2352 by 1568 pixels, 45° FOV:
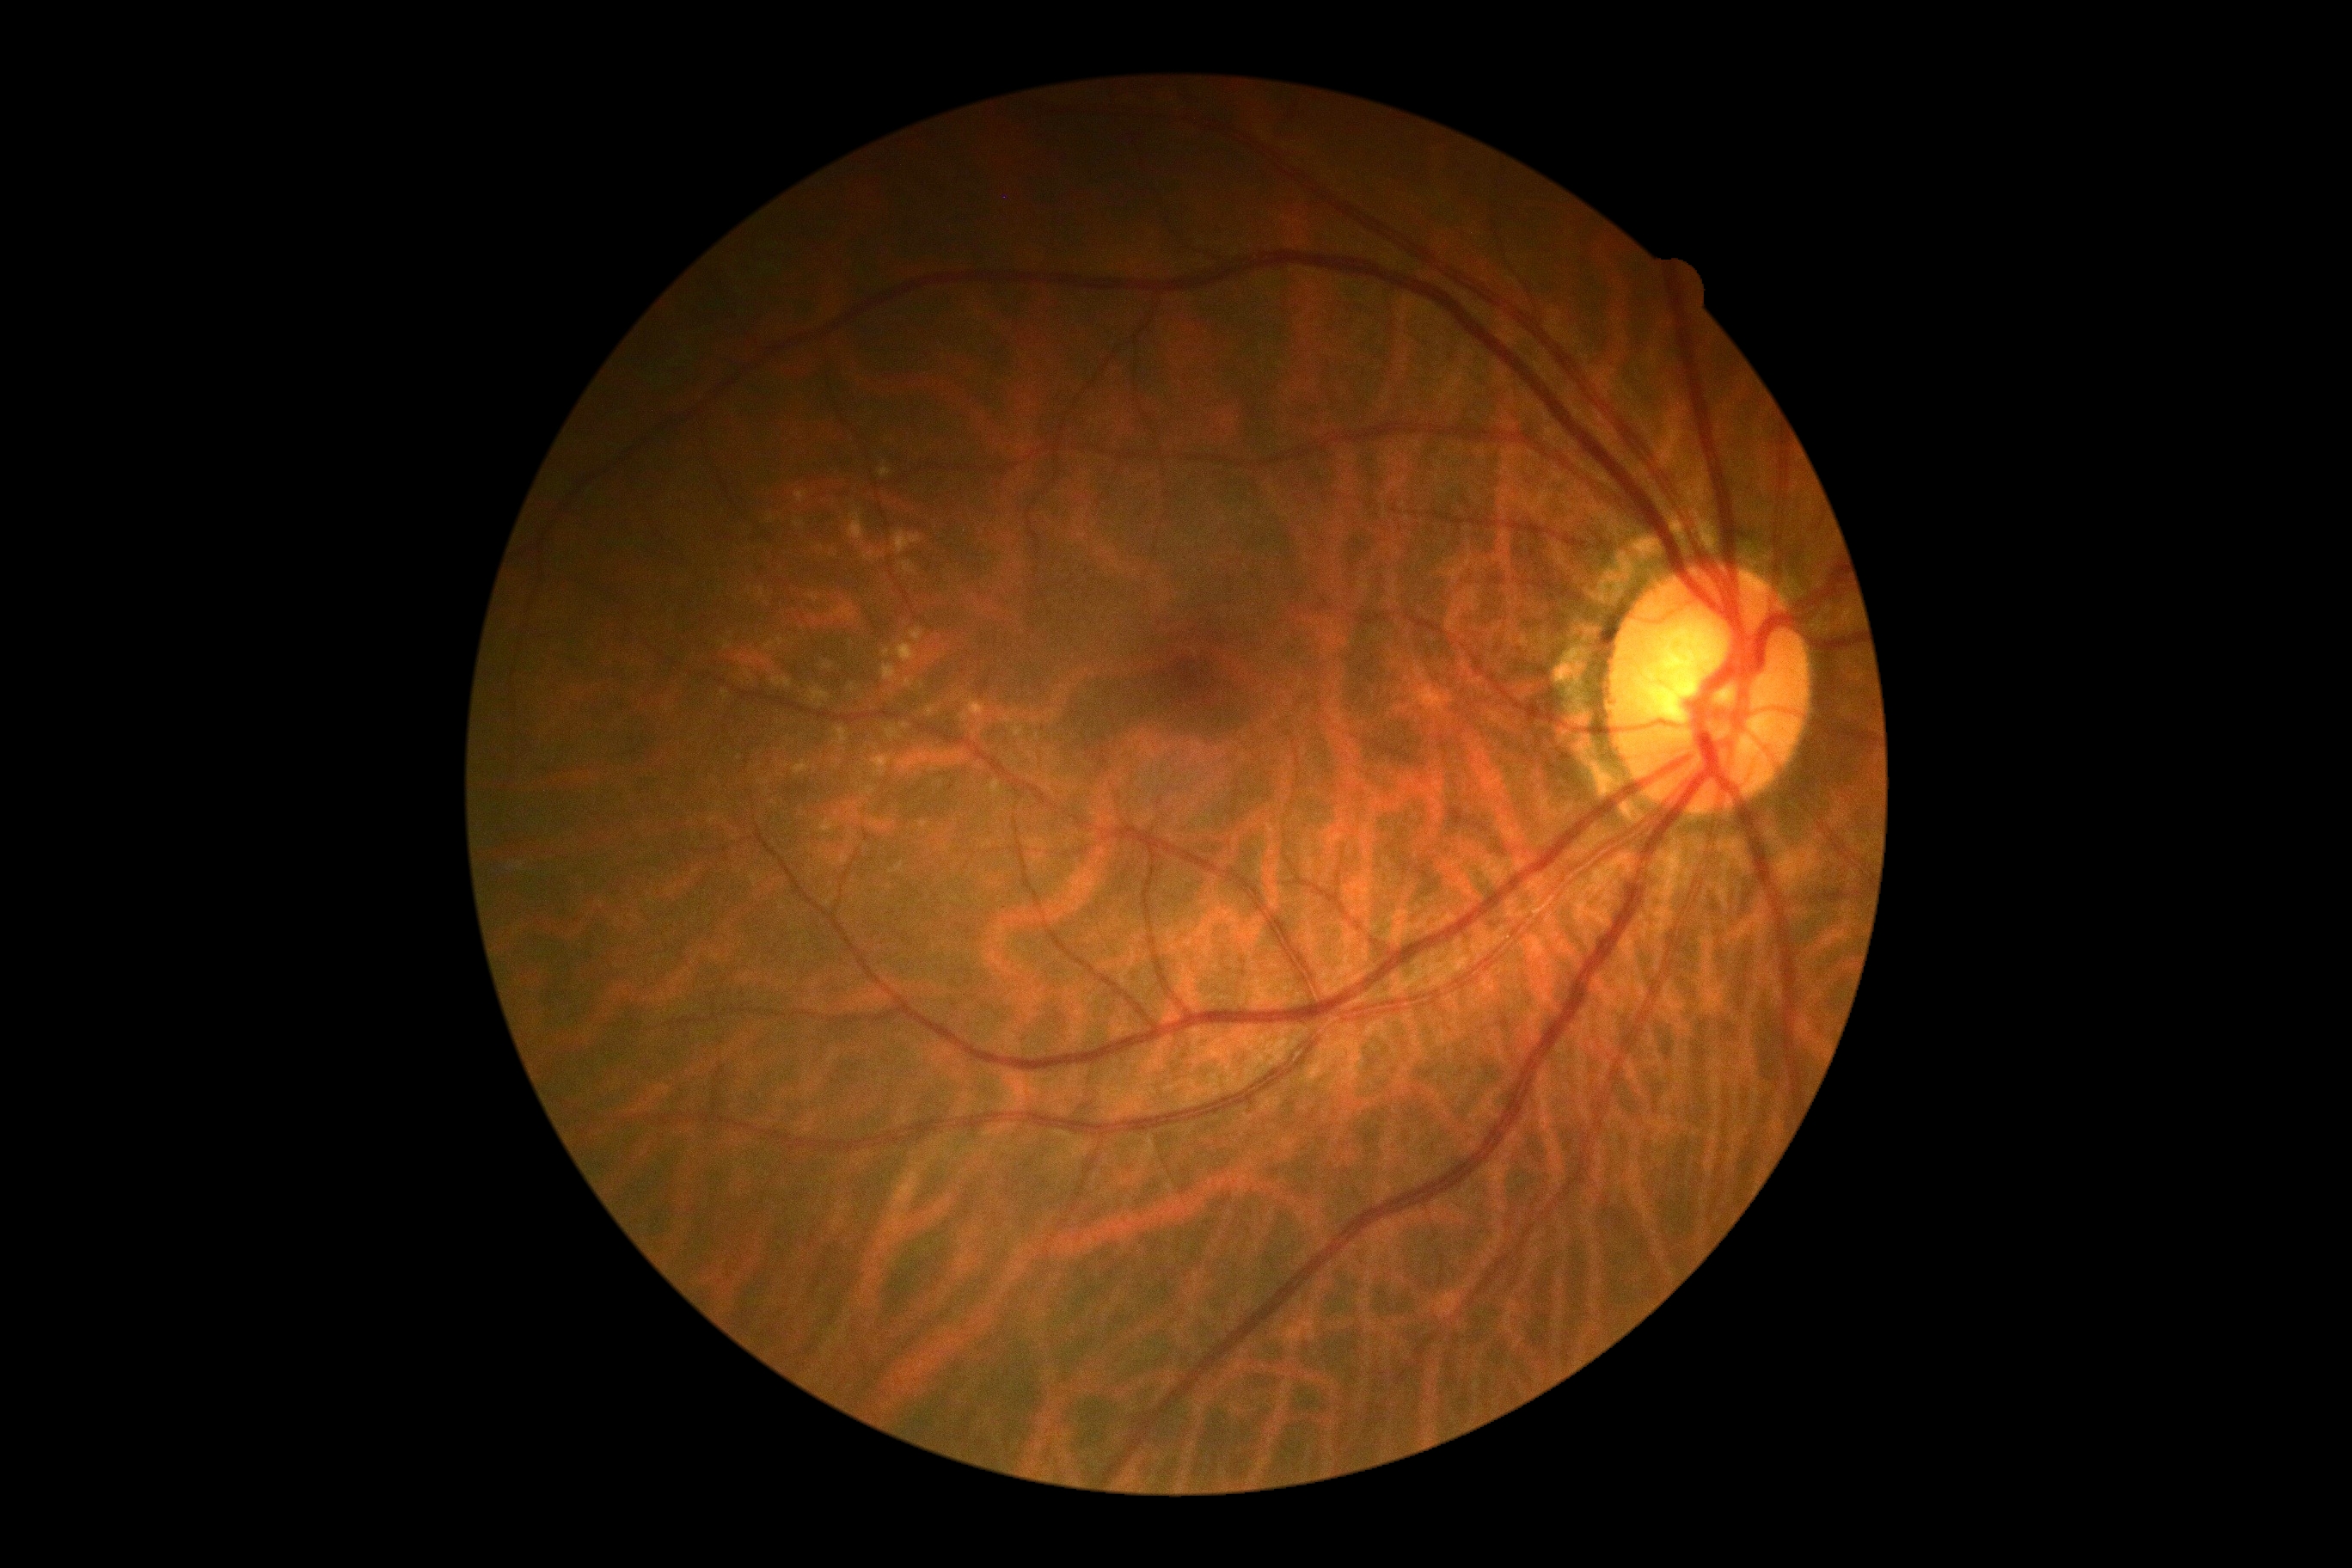 Diabetic retinopathy (DR) is no apparent diabetic retinopathy (grade 0).